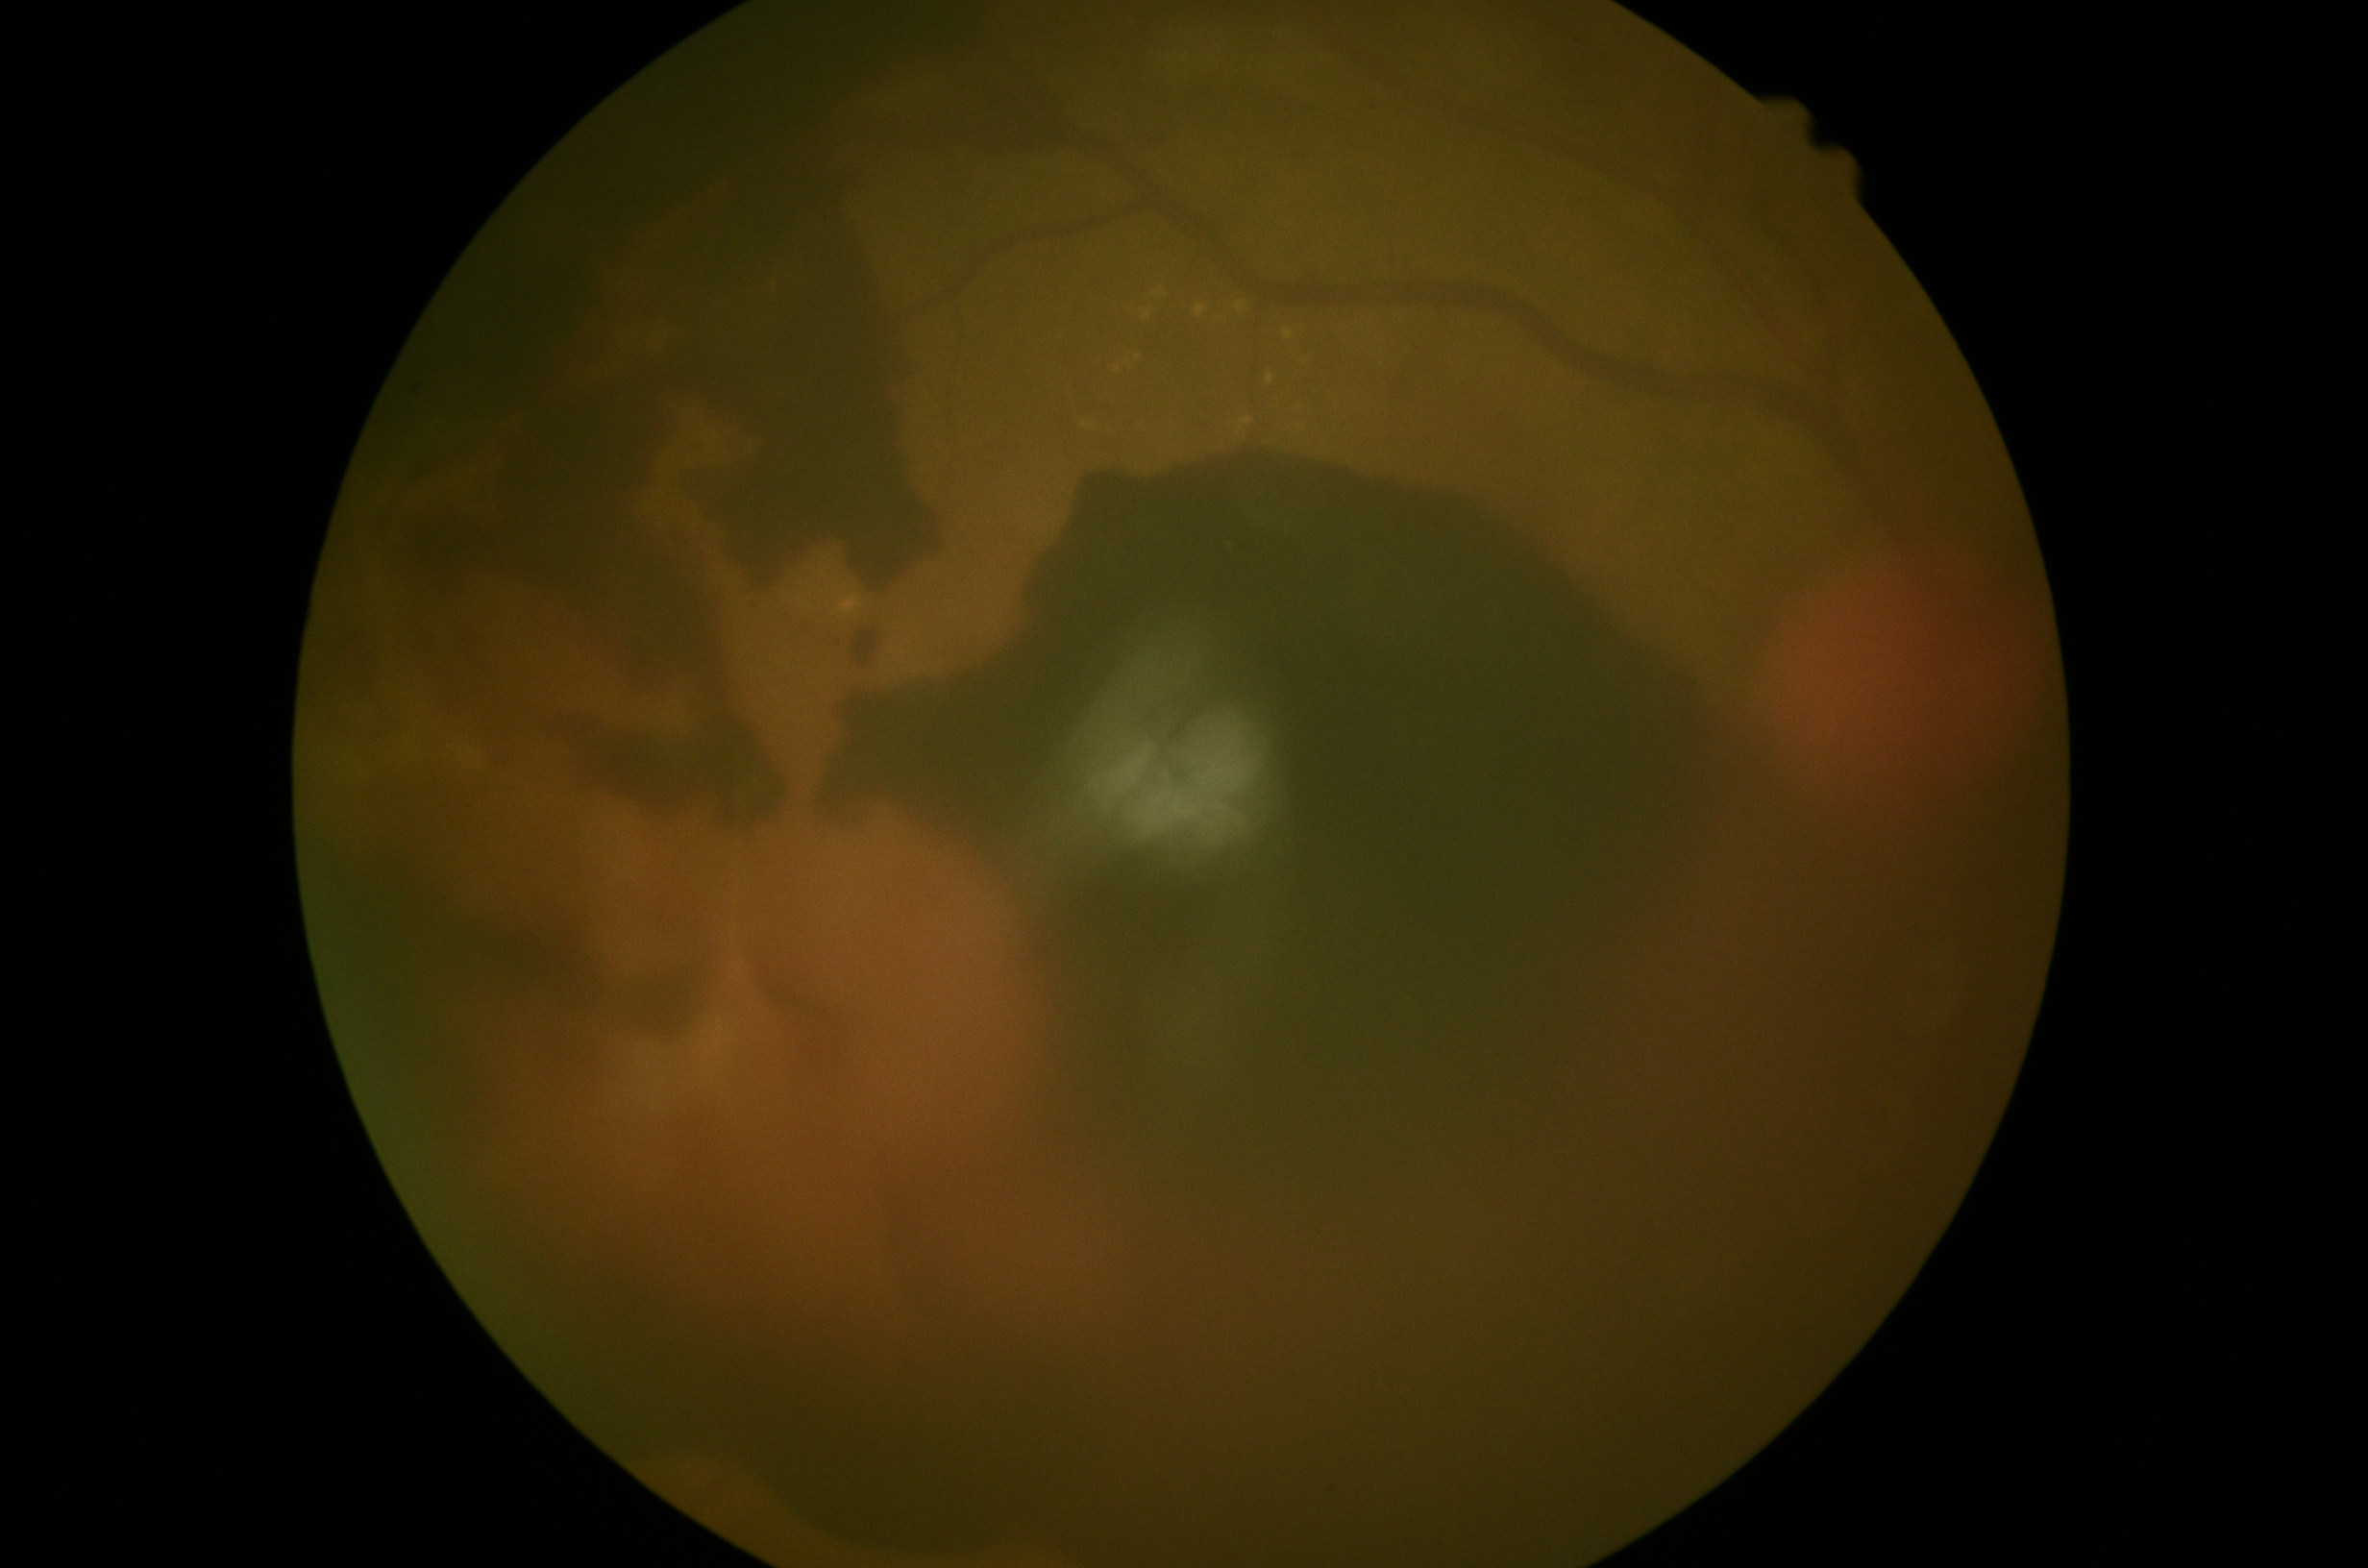 Diabetic retinopathy grade: PDR (4).